Color fundus image; FOV: 45 degrees — 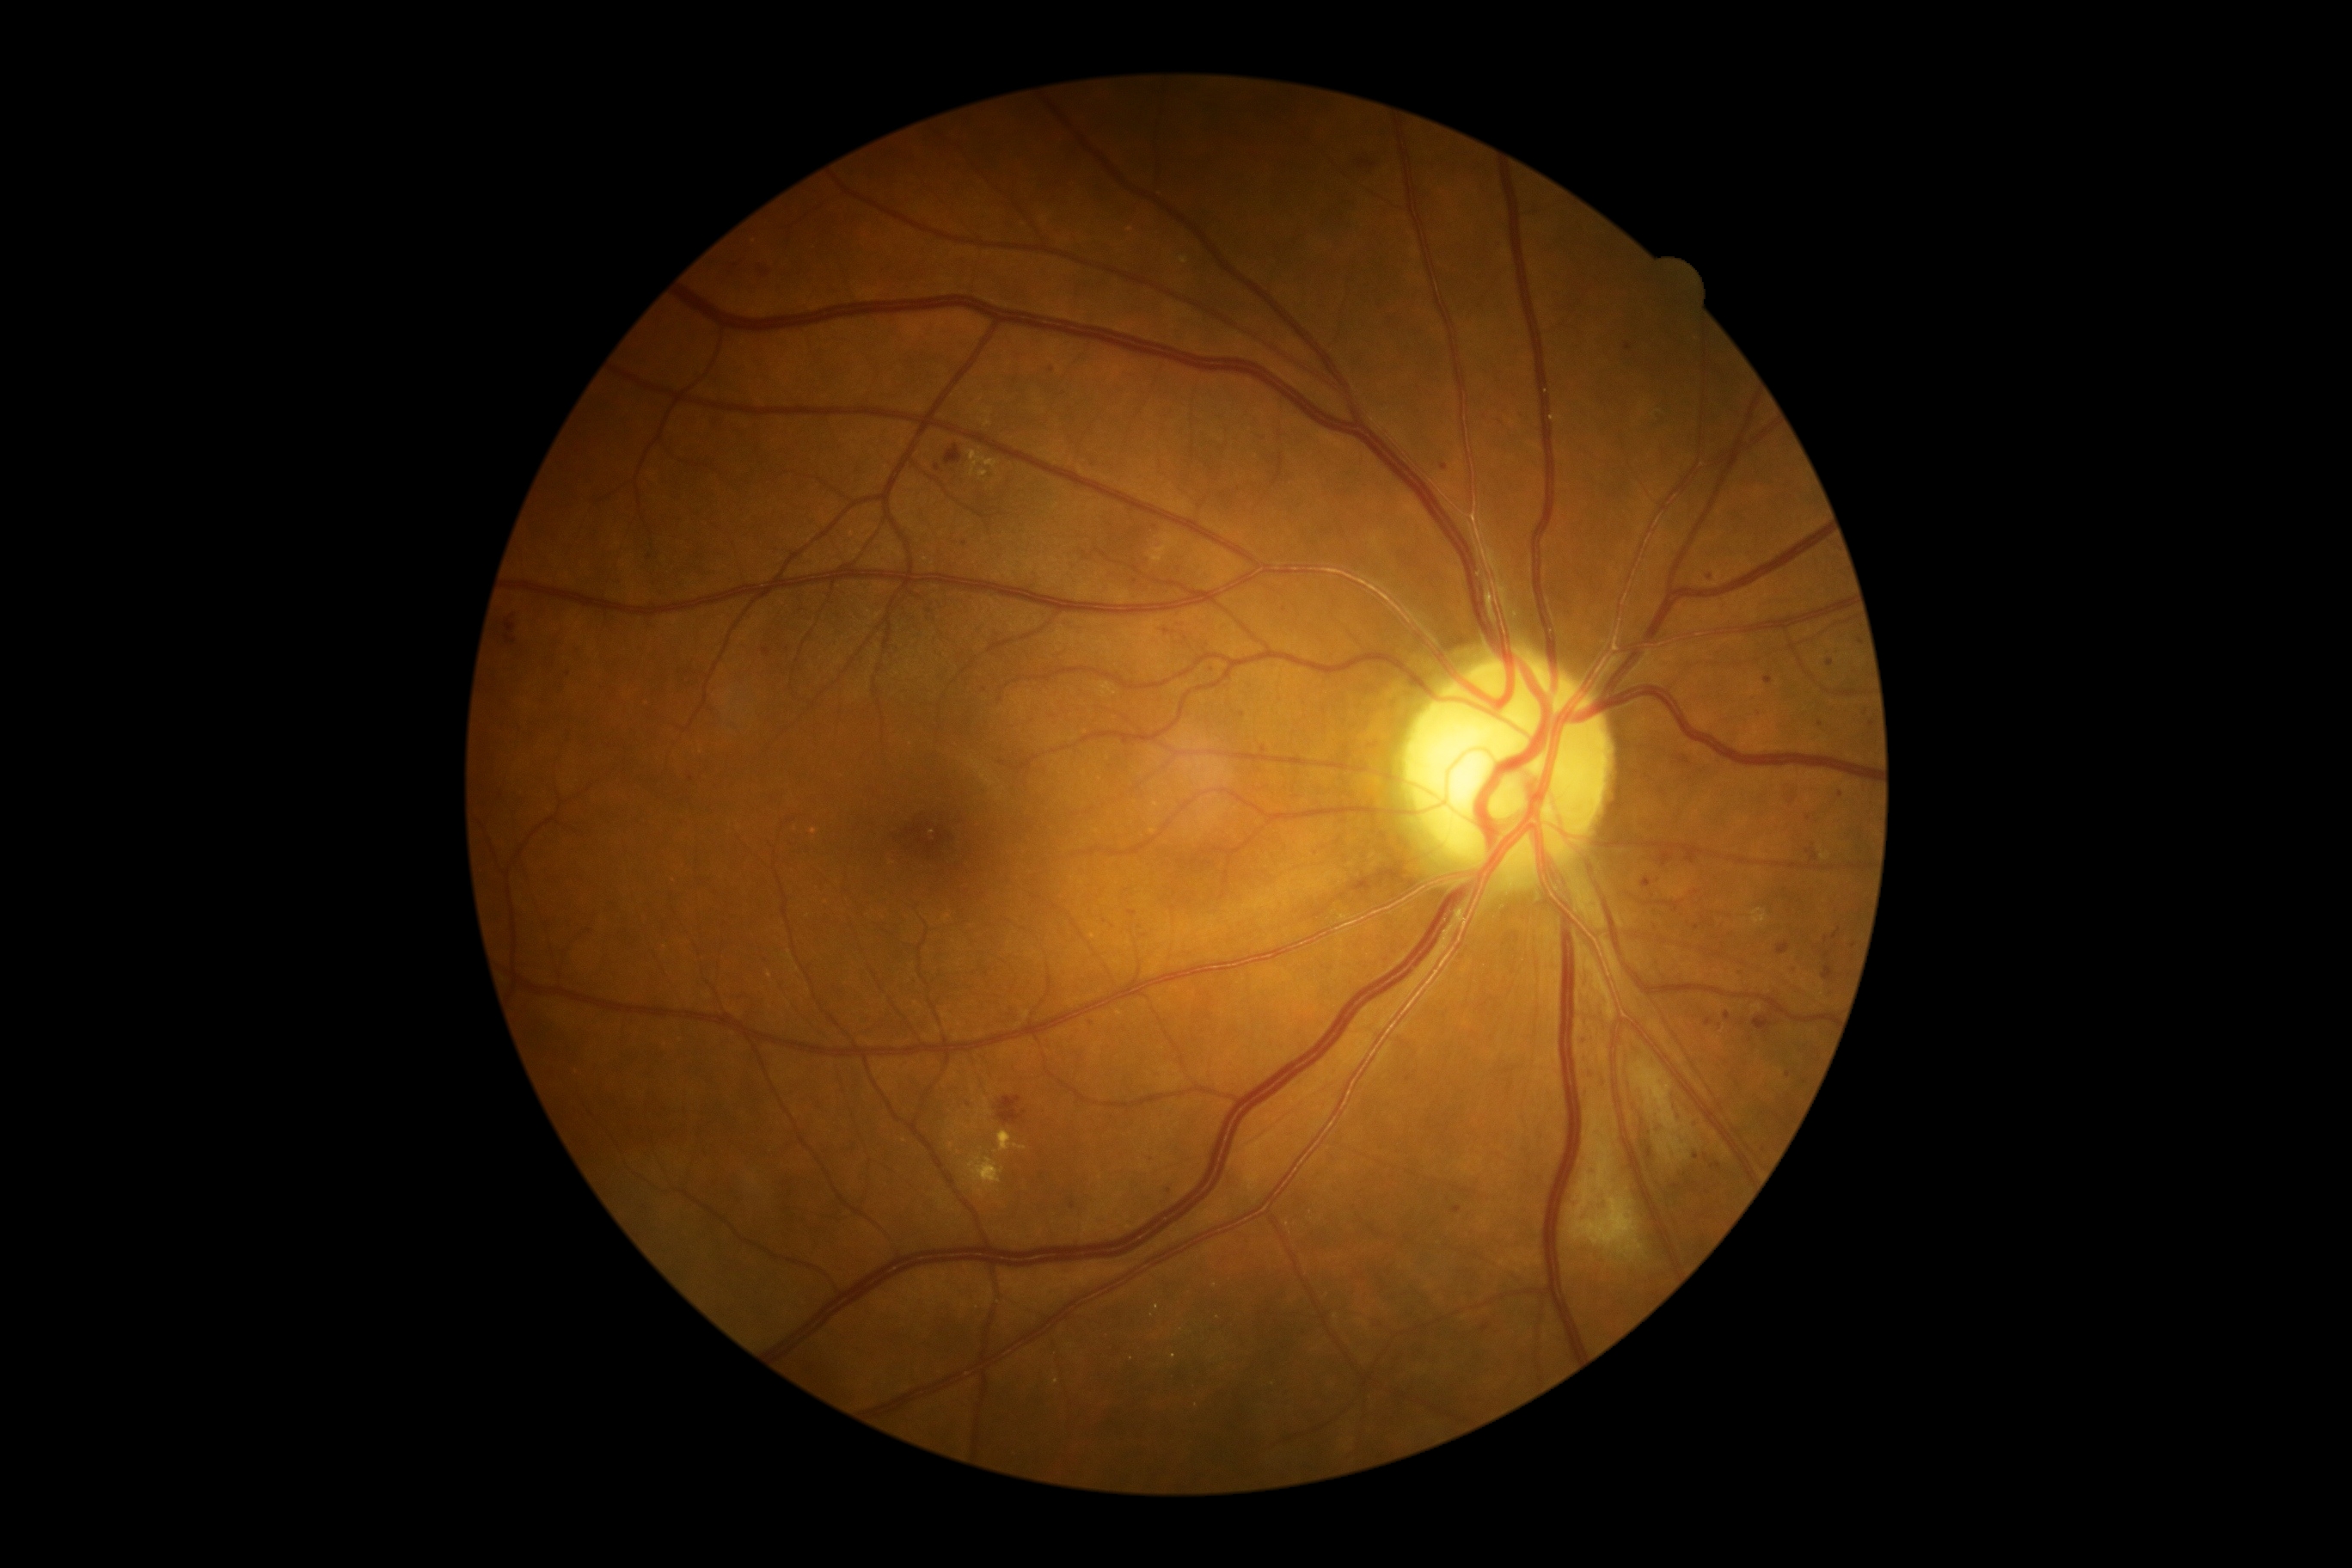

DR stage is grade 2
Selected lesions:
EXs (continued): bbox=[969, 451, 998, 477], bbox=[967, 1155, 1005, 1191], bbox=[976, 1189, 984, 1197], bbox=[998, 1130, 1027, 1151], bbox=[977, 470, 988, 479]
HEs: bbox=[945, 446, 962, 465], bbox=[1753, 1017, 1773, 1034], bbox=[998, 1096, 1026, 1125]
SEs: bbox=[1591, 1115, 1600, 1132], bbox=[1598, 1158, 1608, 1189], bbox=[1631, 1062, 1696, 1165], bbox=[1577, 1179, 1595, 1213], bbox=[1598, 1144, 1608, 1155], bbox=[1572, 1197, 1645, 1261]
Small SEs near pt(1593, 1142)
MAs (continued): bbox=[1725, 1012, 1732, 1020], bbox=[1870, 721, 1873, 730], bbox=[1705, 1017, 1713, 1026], bbox=[1179, 622, 1187, 627], bbox=[1452, 1206, 1462, 1215], bbox=[1660, 852, 1674, 867], bbox=[506, 616, 517, 634], bbox=[1584, 1034, 1591, 1046]
Small MAs near pt(1486, 1328), pt(937, 468), pt(1243, 715), pt(1589, 1094), pt(1710, 577), pt(1487, 417), pt(1841, 794), pt(969, 1104), pt(1677, 910), pt(1866, 711), pt(1854, 946)